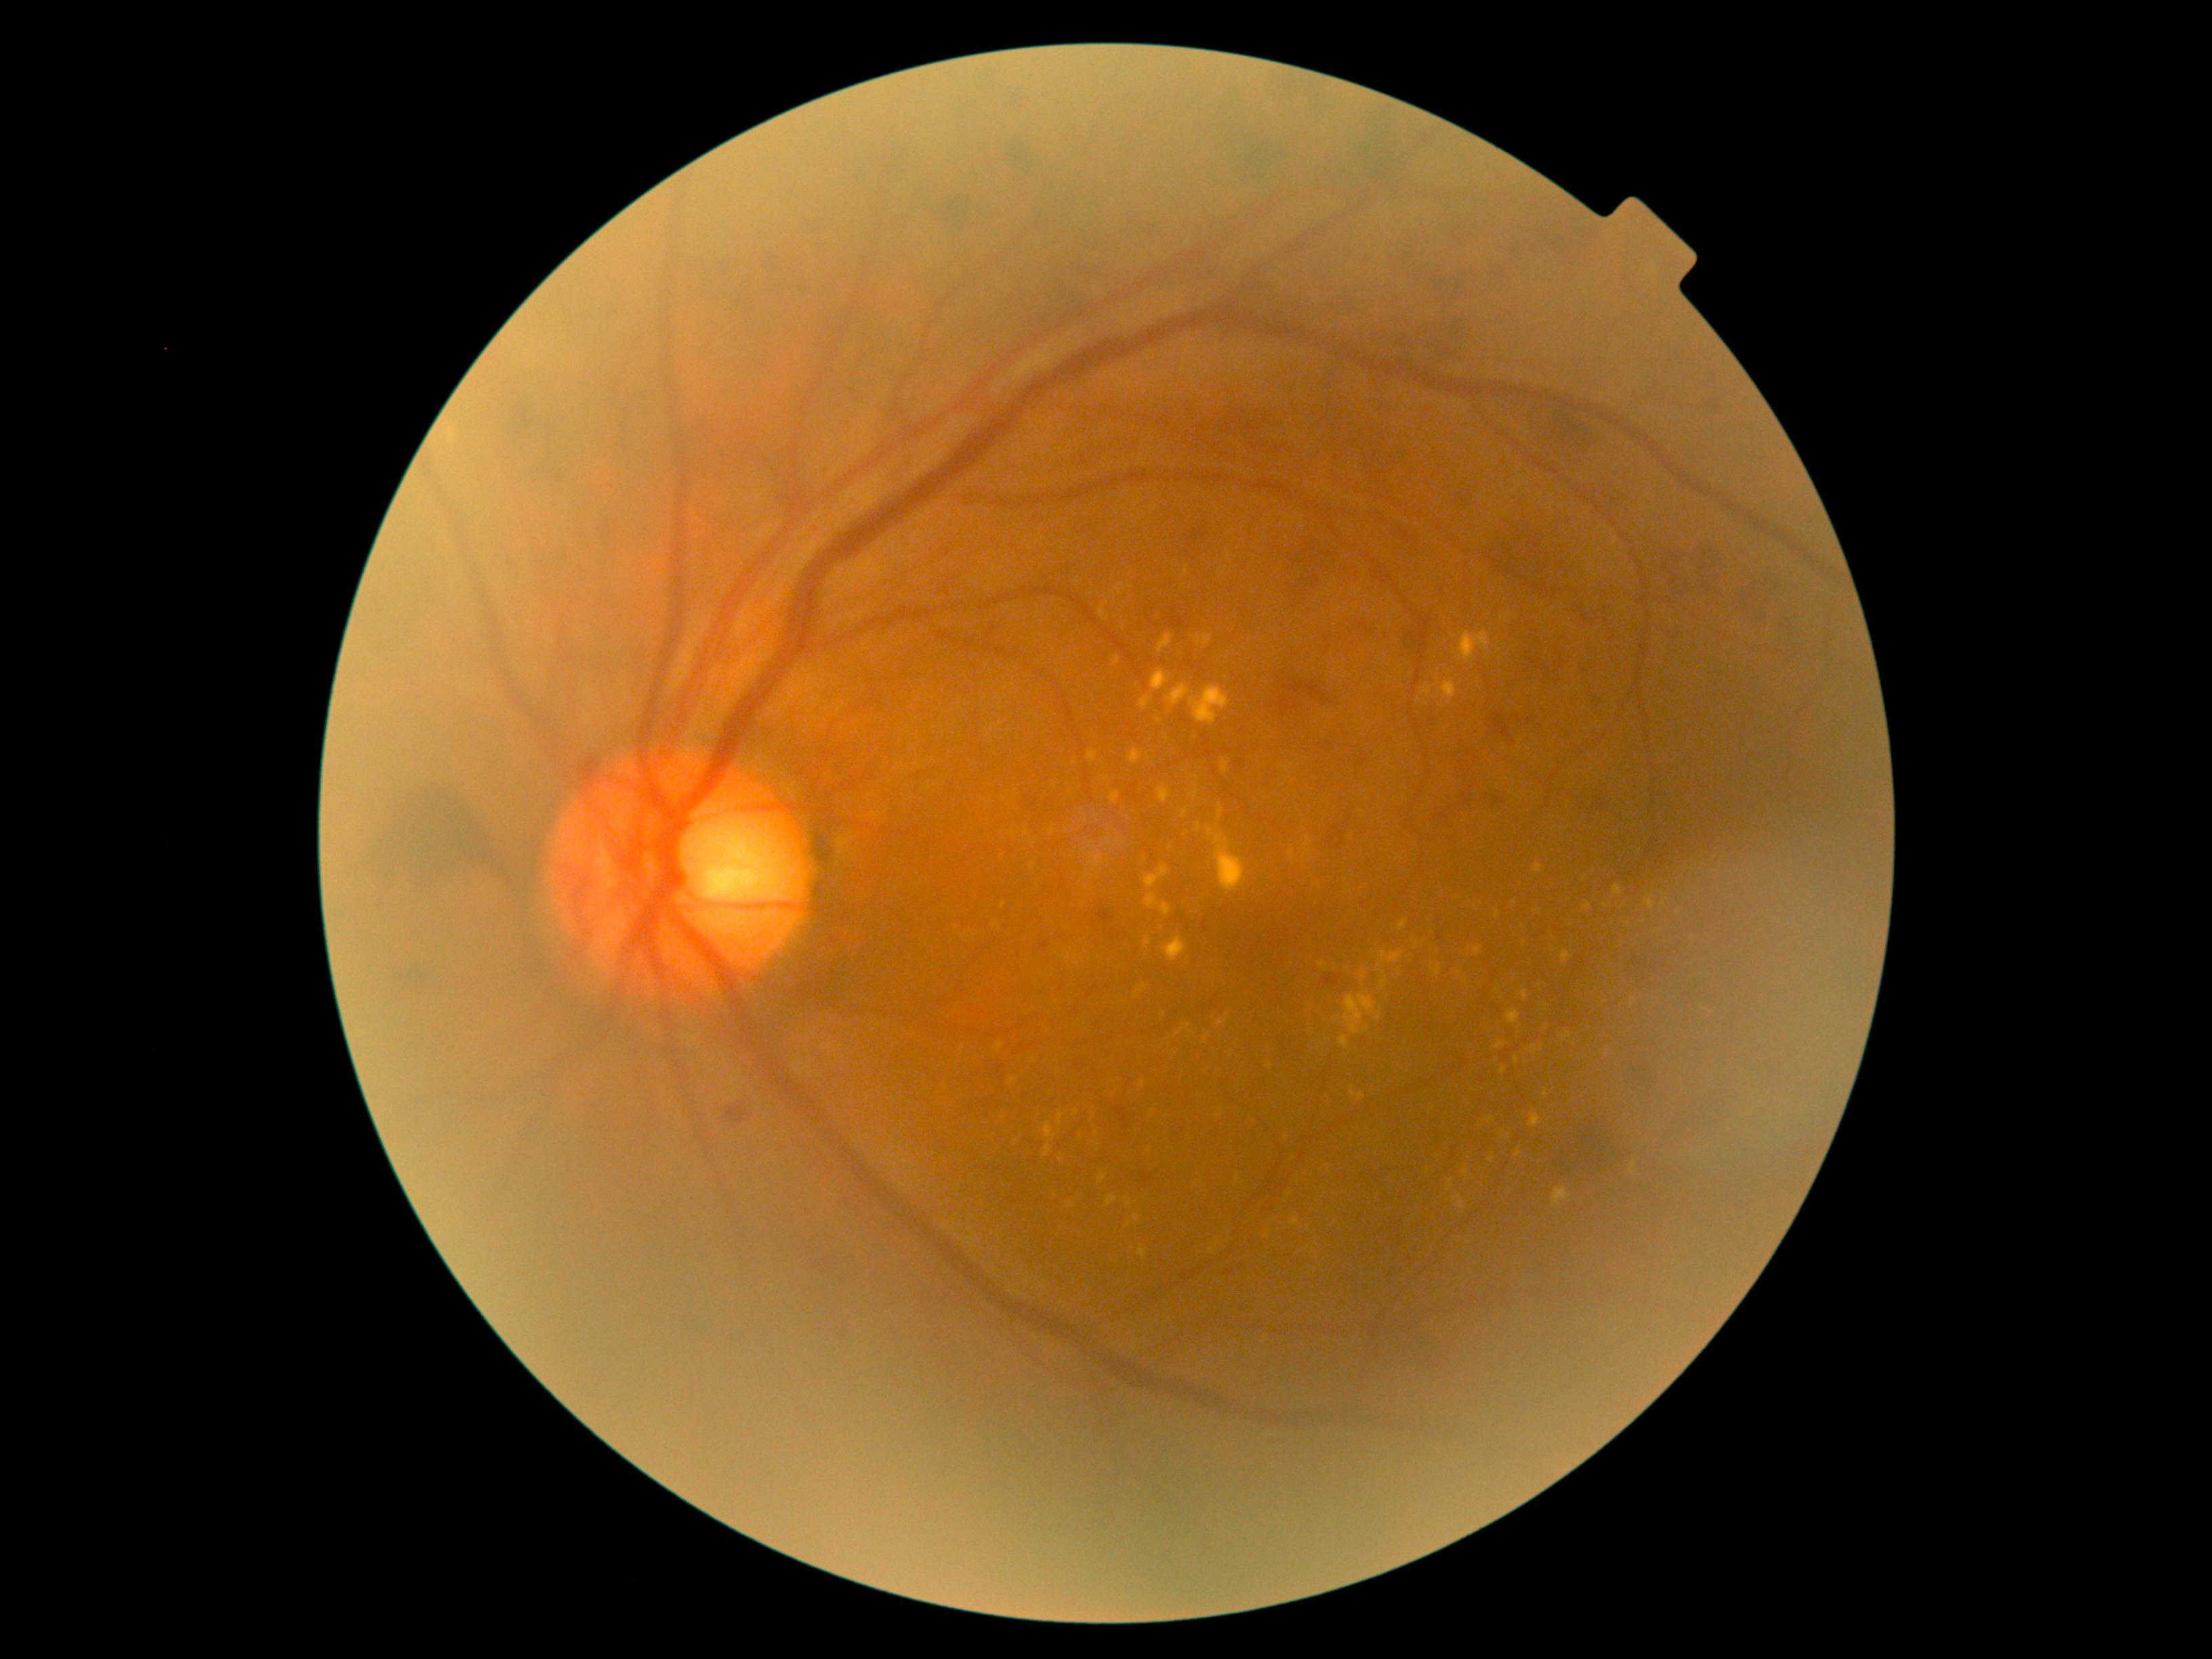

DR class=non-proliferative diabetic retinopathy; retinopathy=2/4 — more than just microaneurysms but less than severe NPDR.